Davis DR grading: 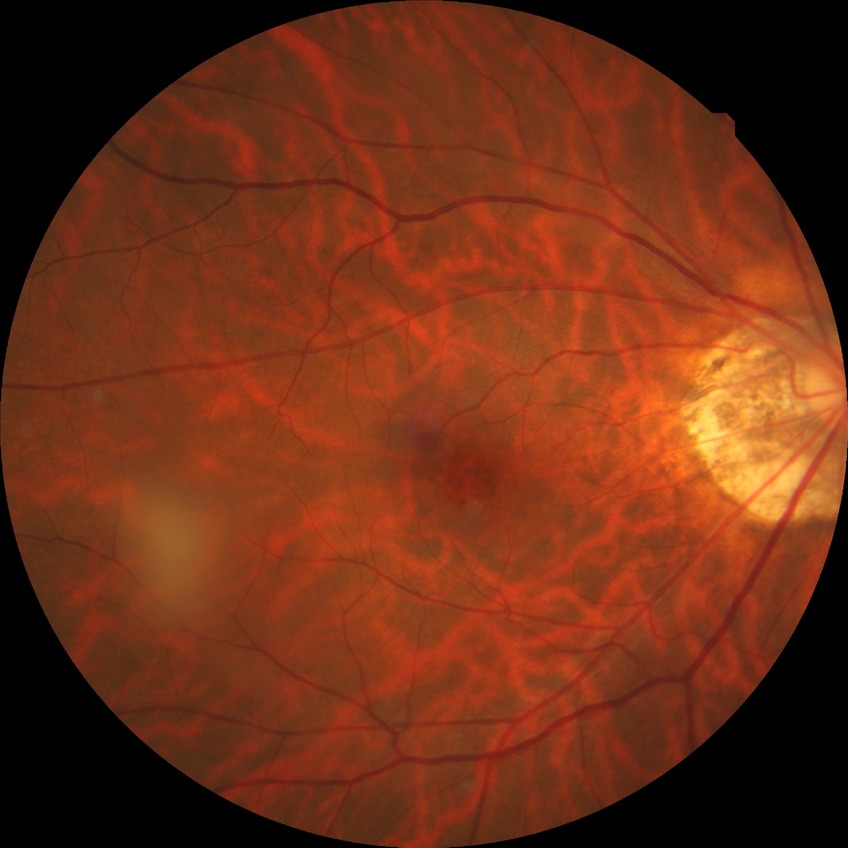

Annotations:
– diabetic retinopathy (DR): no diabetic retinopathy (NDR)